Wide-field fundus photograph from neonatal ROP screening; Phoenix ICON, 100° FOV; 1240 by 1240 pixels
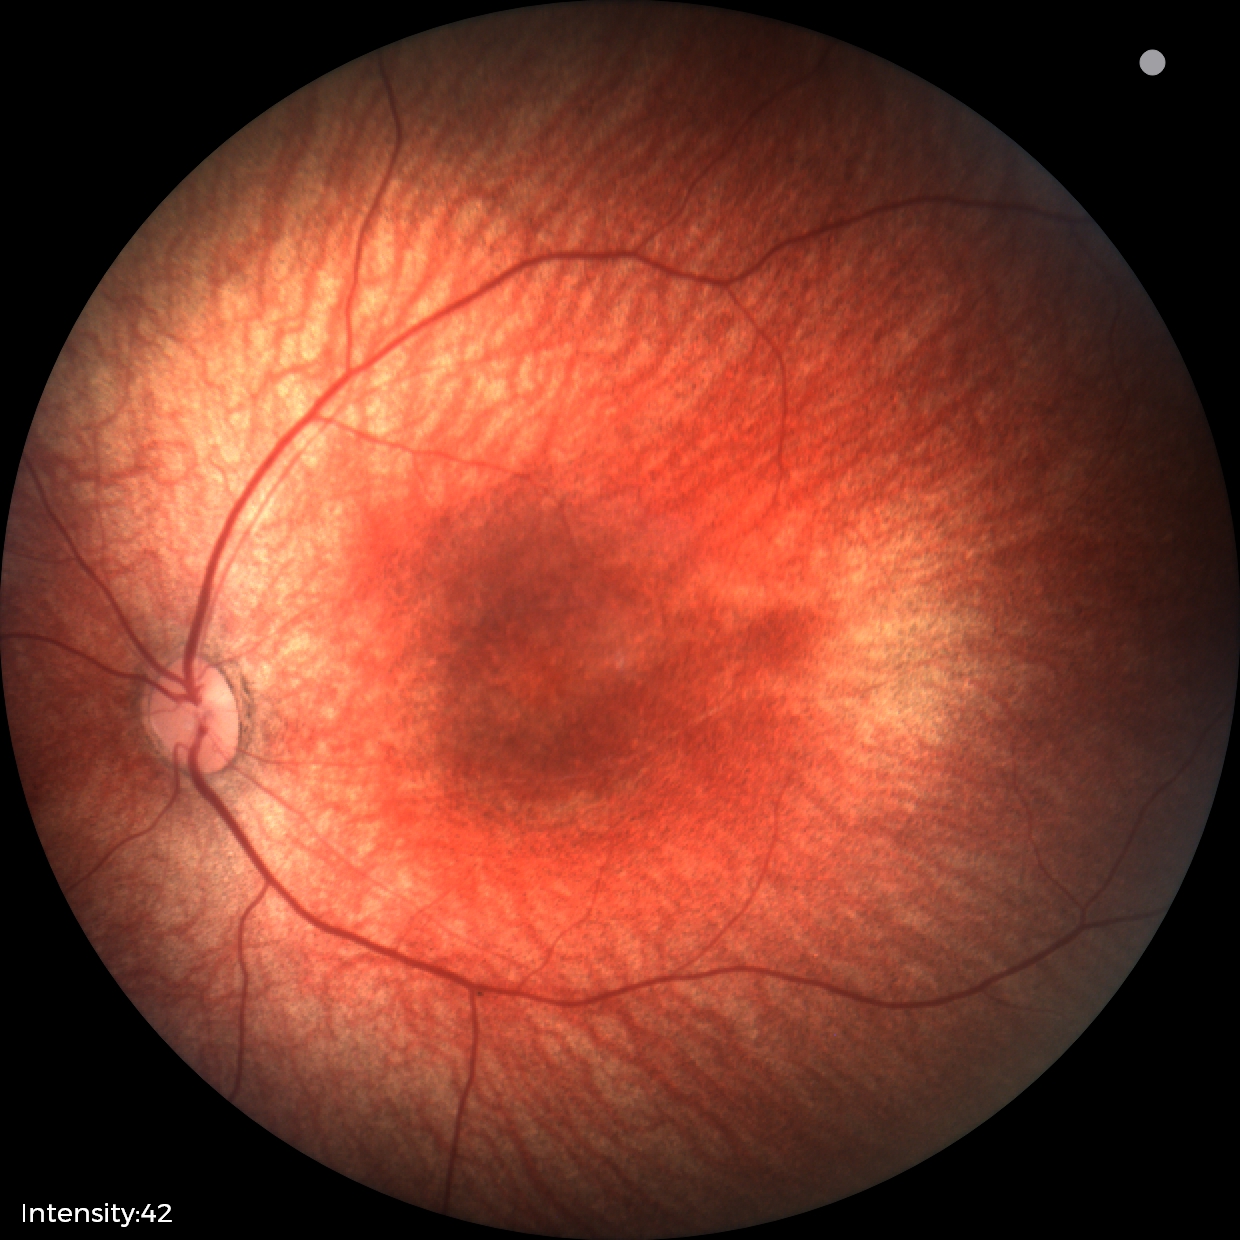

Screening examination with no abnormal retinal findings.